512x512px:
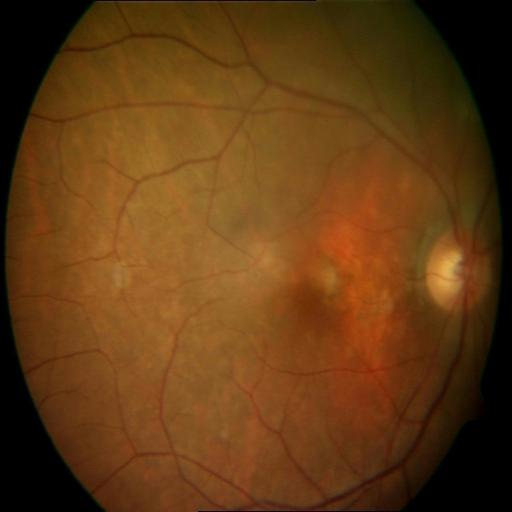
The image shows microaneurysms (MCA).